Retinal fundus photograph: 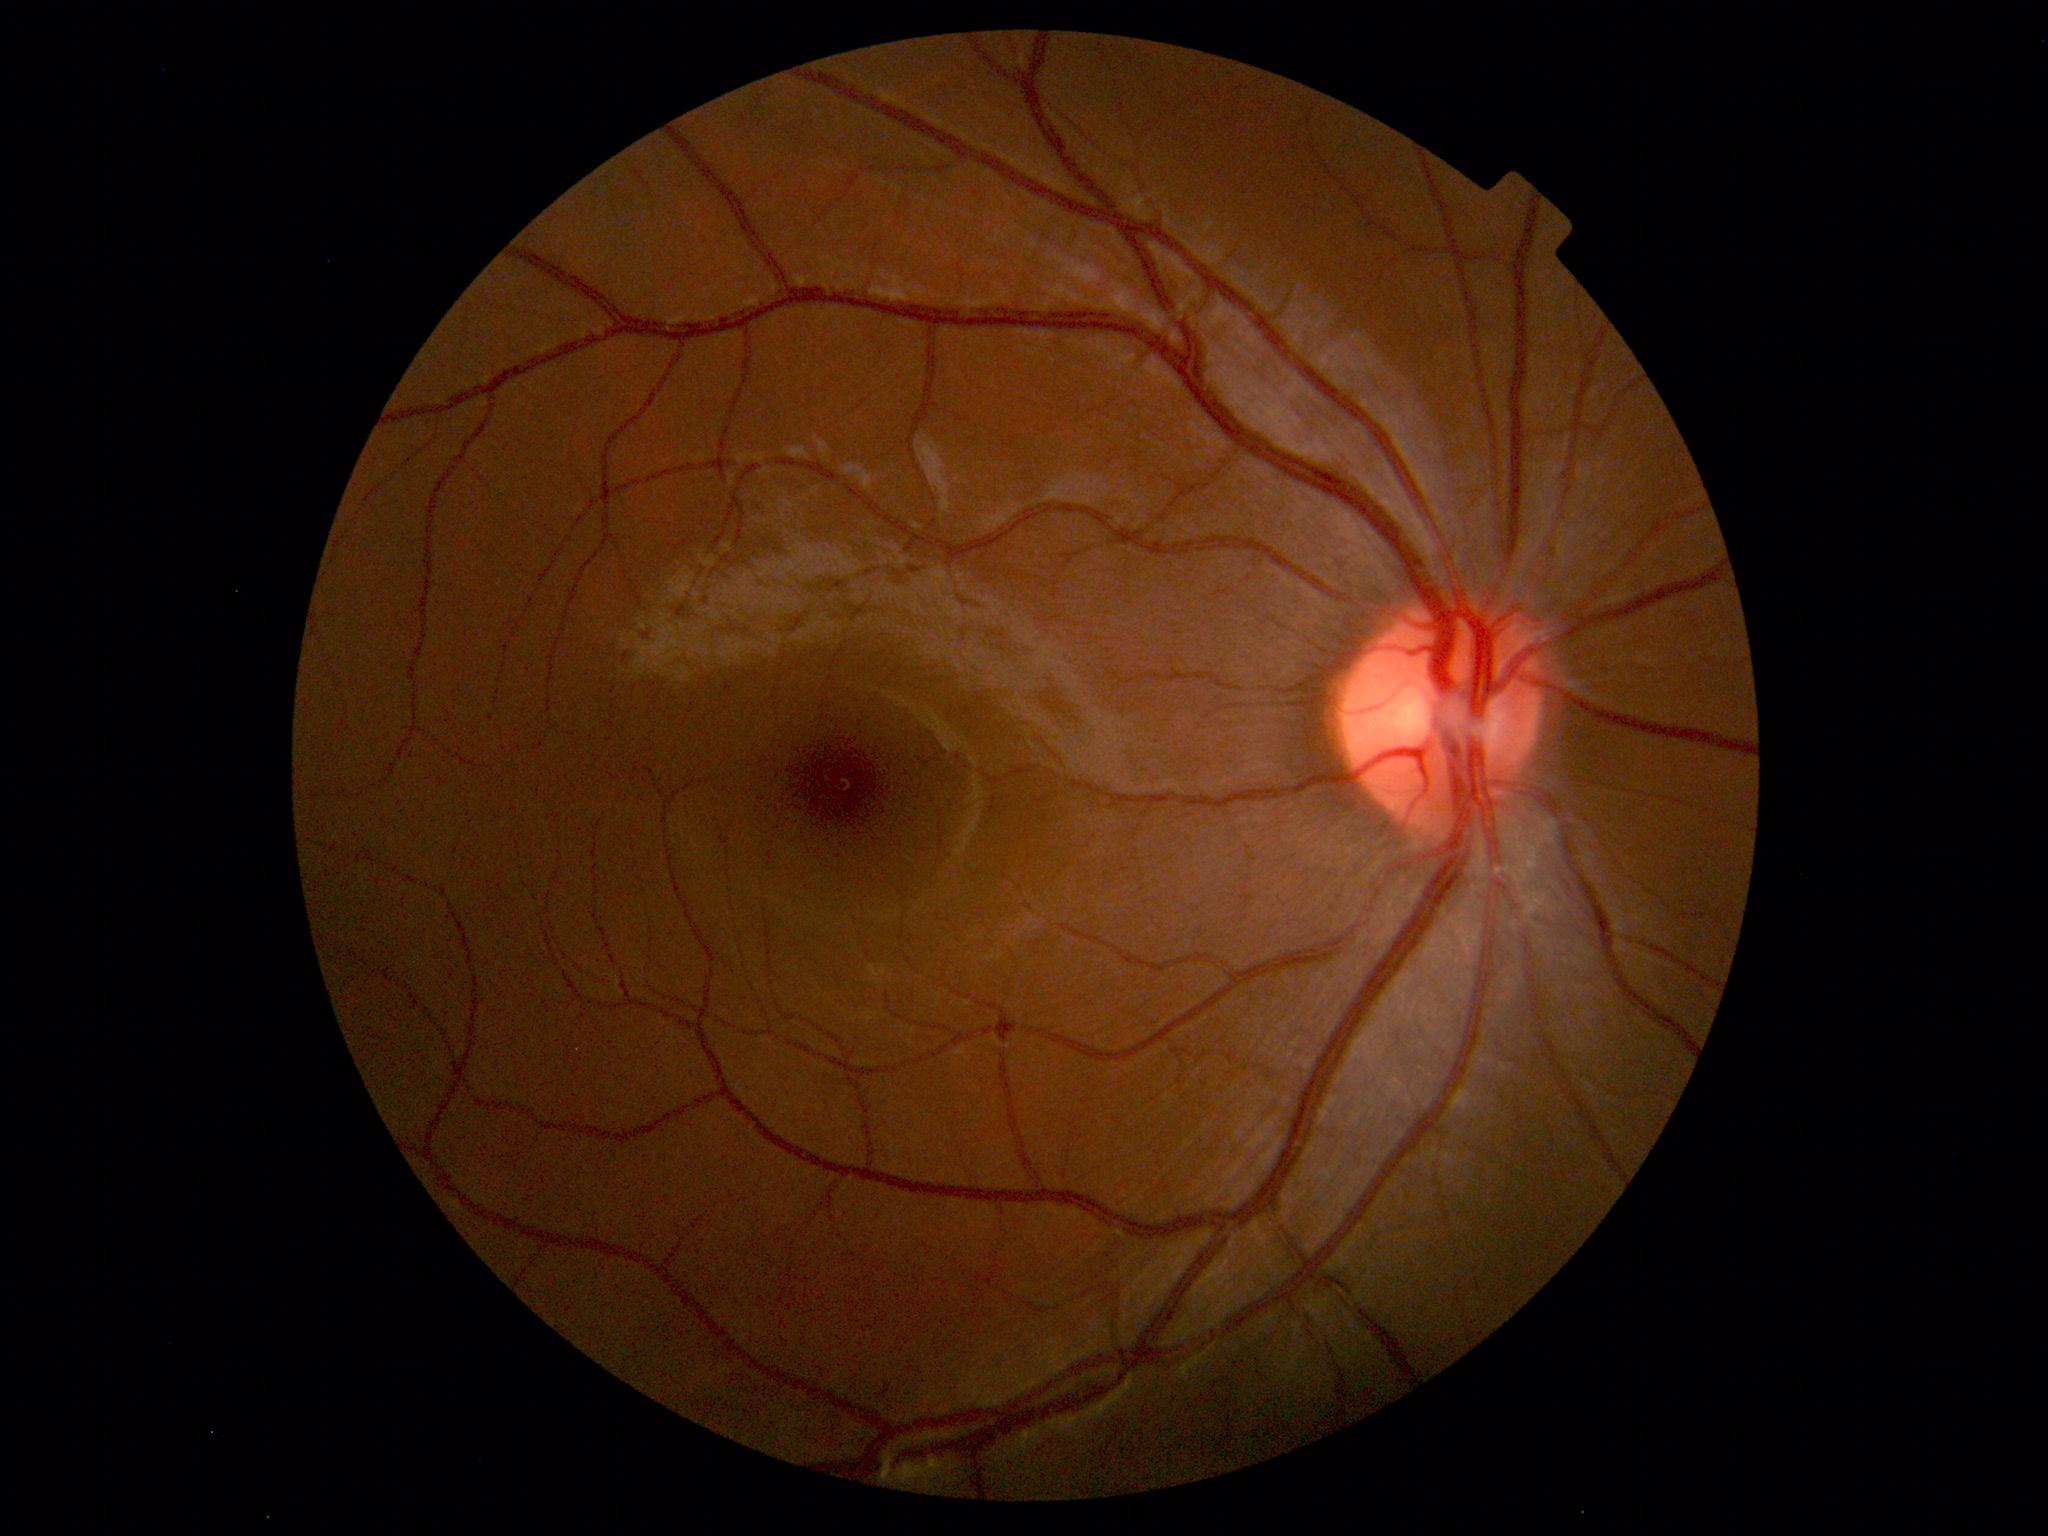 No retinal pathology identified.